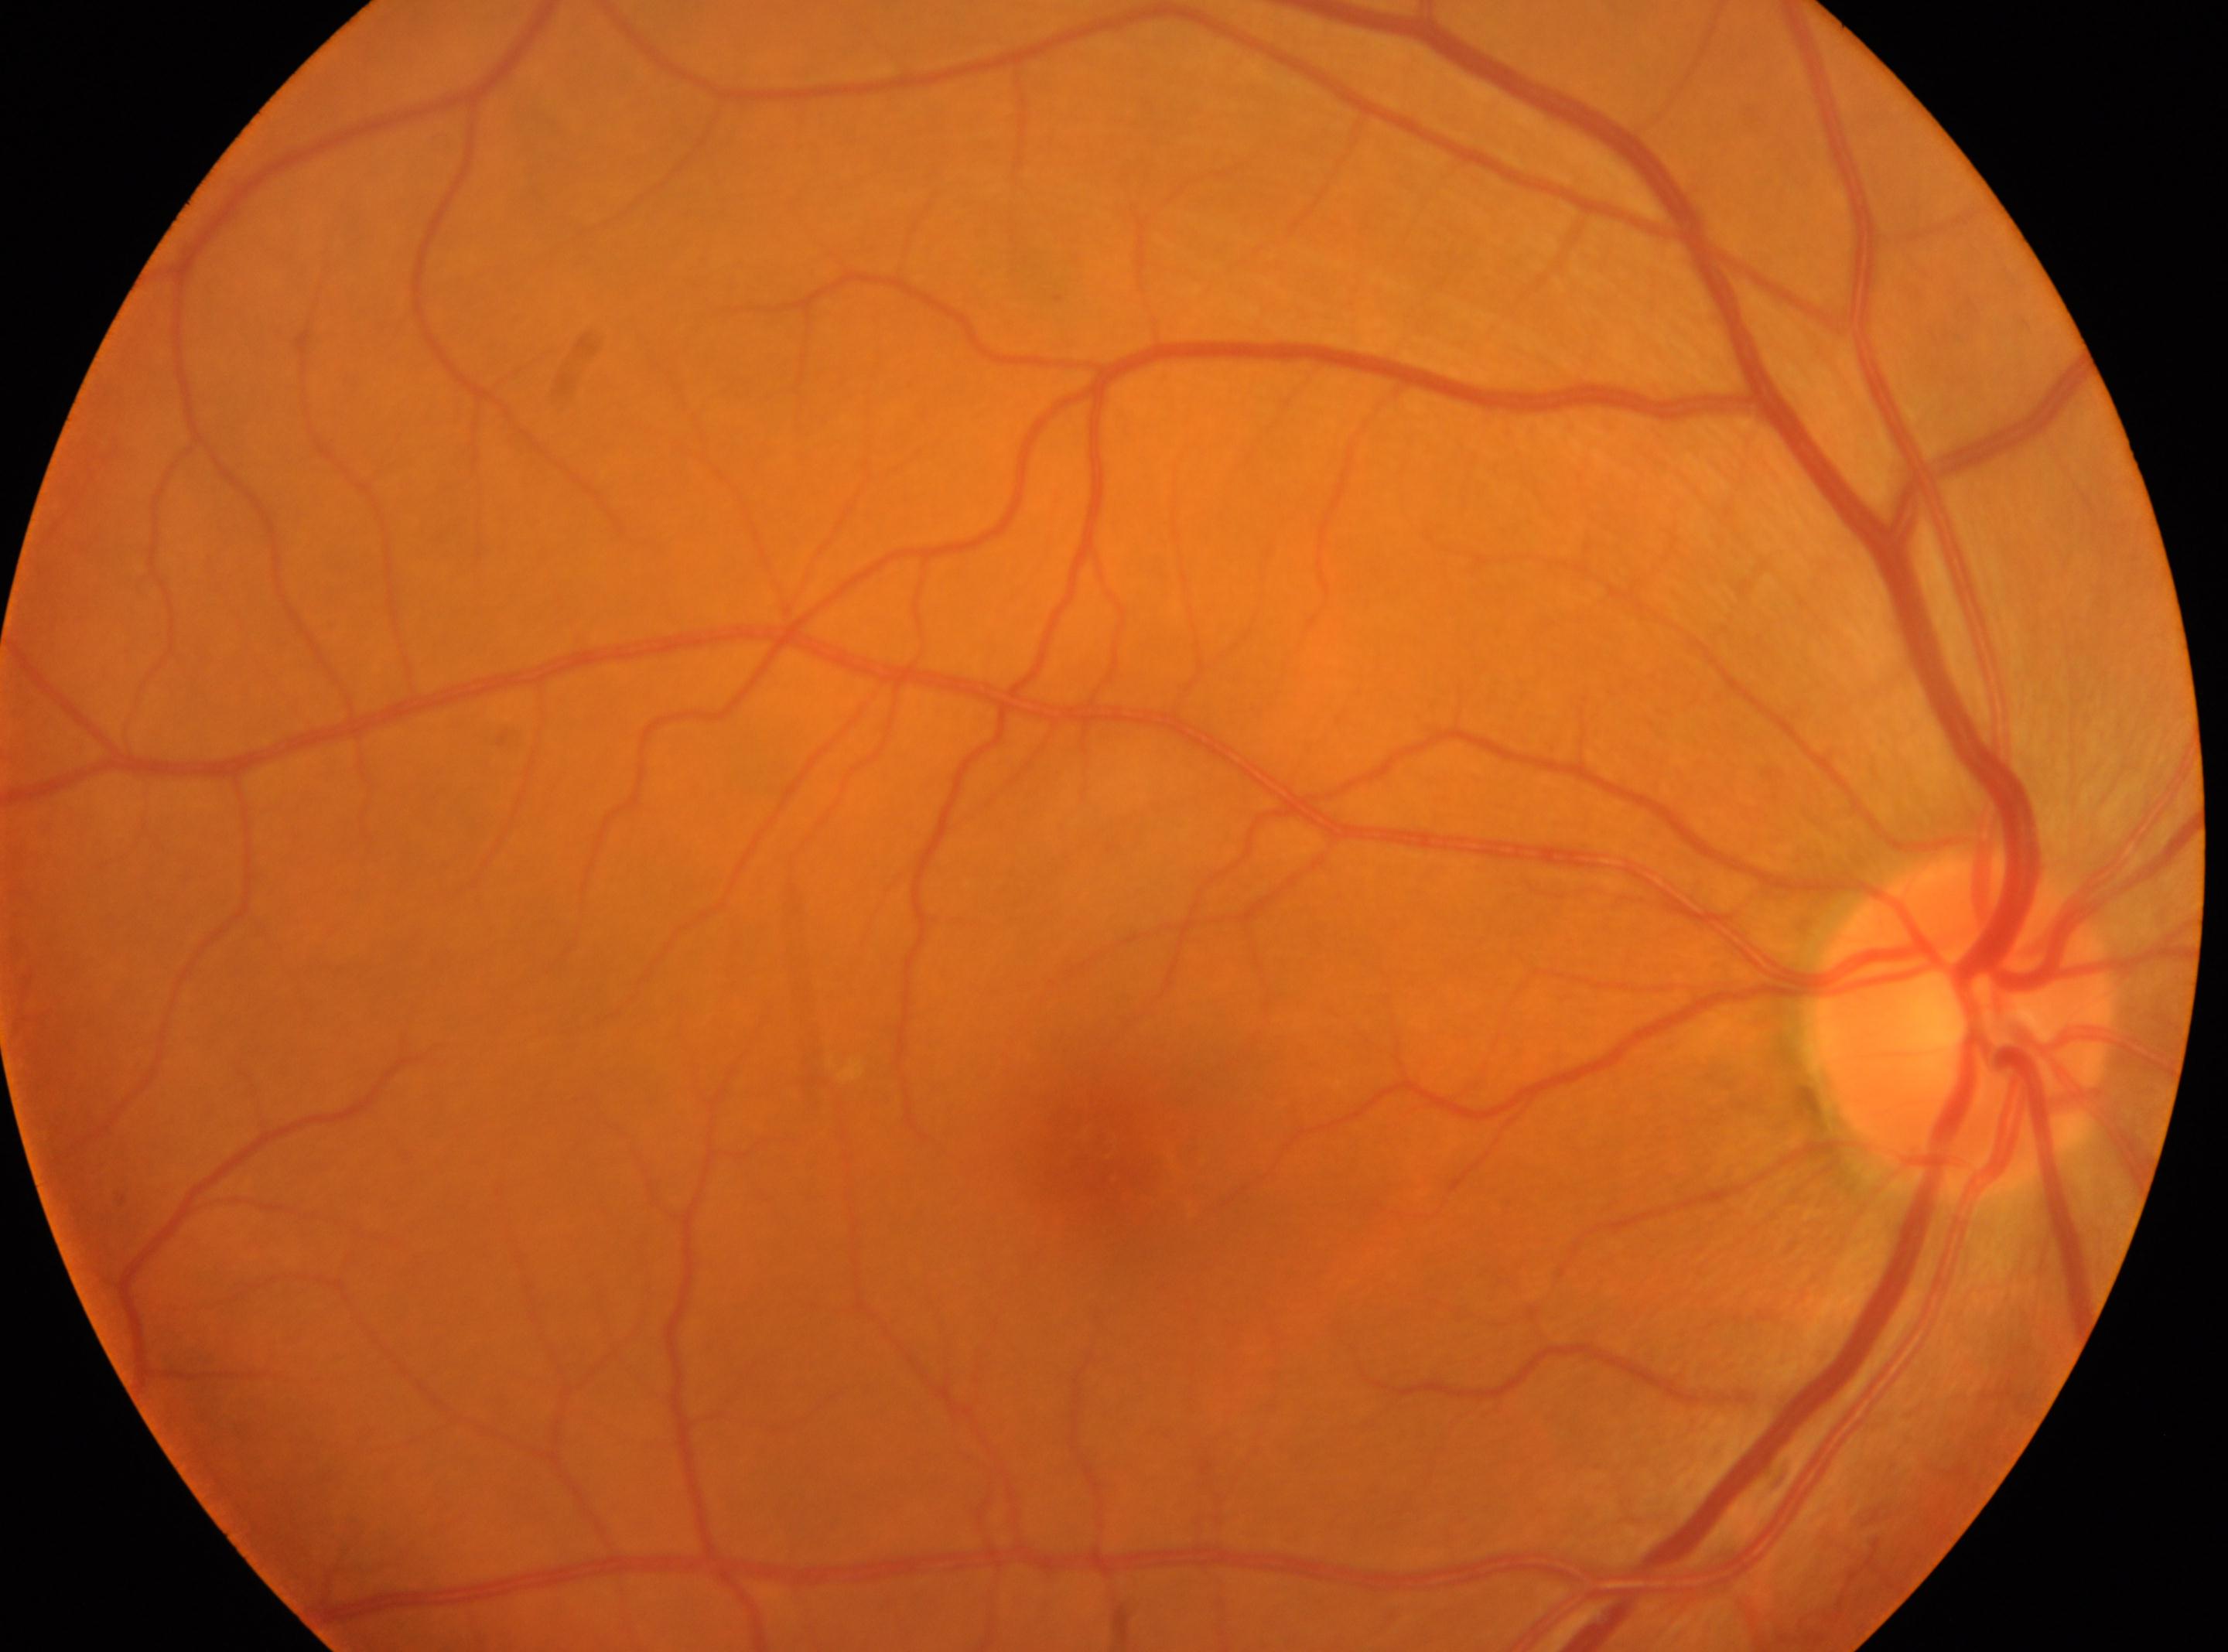

fovea centralis: (x=1125, y=1159) | DR grade: no apparent retinopathy (0) | No apparent diabetic retinopathy | OD | optic disc center: (x=1963, y=1019).